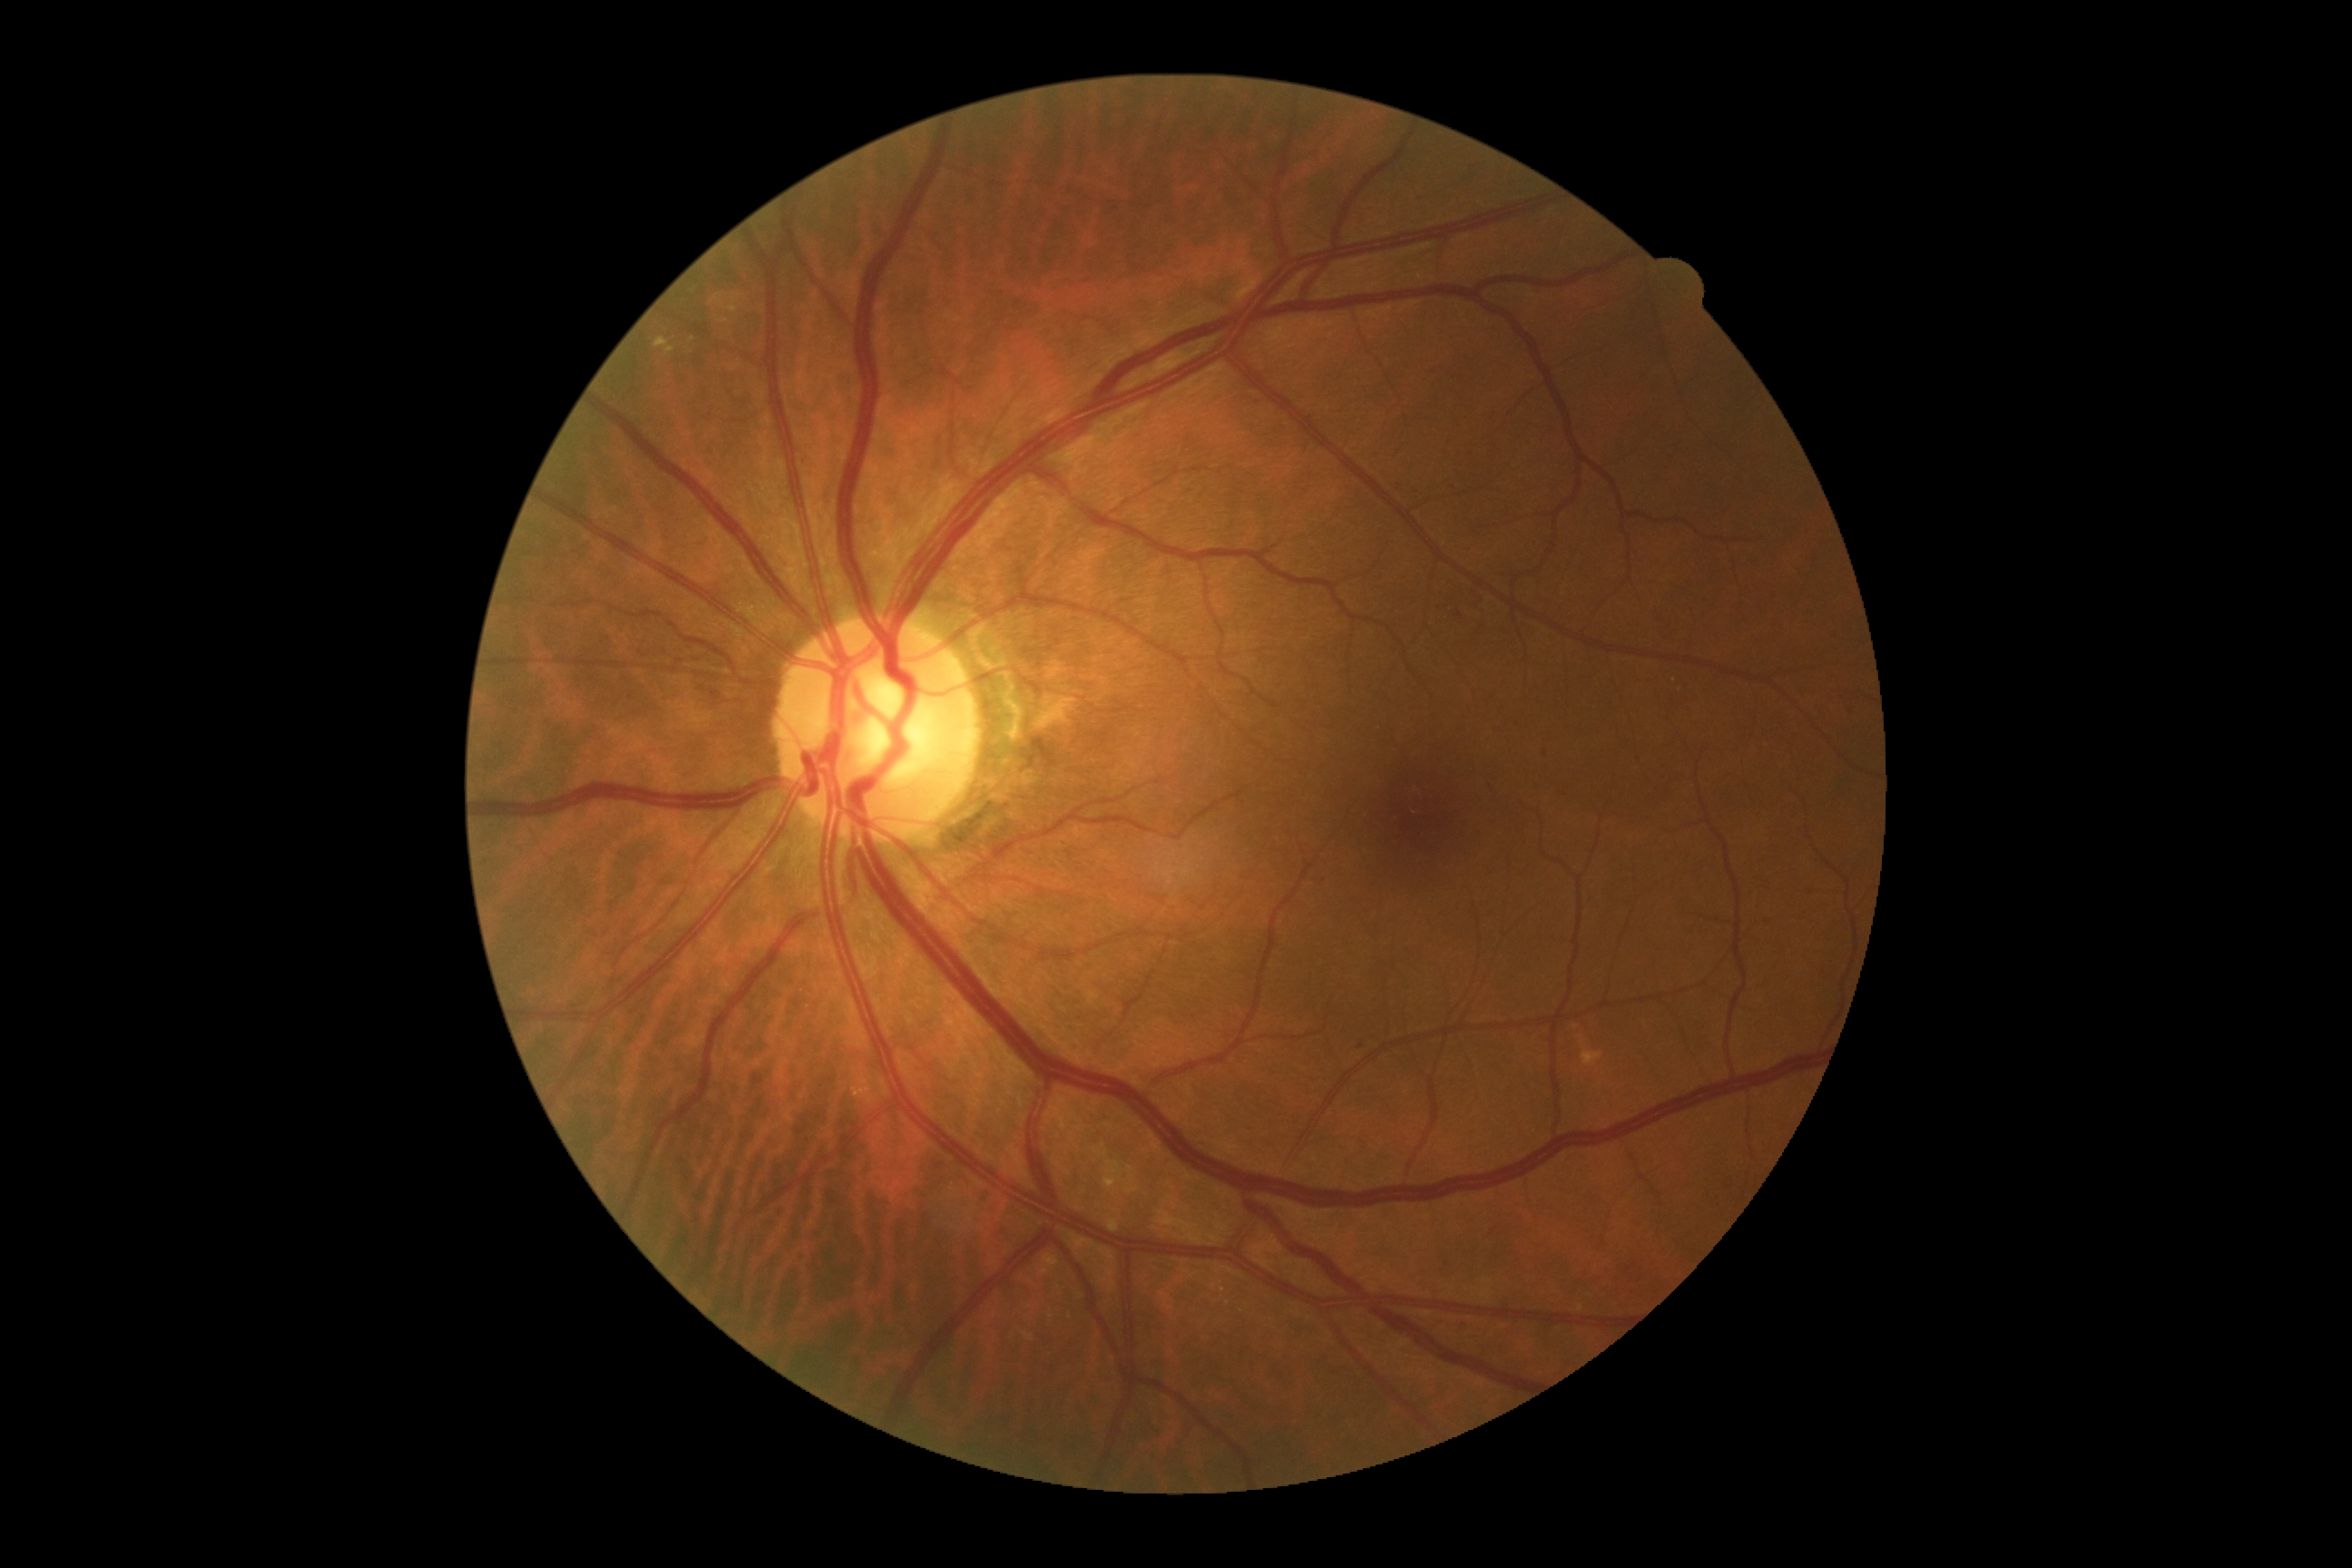
DR class = non-proliferative diabetic retinopathy | retinopathy grade = 2 (moderate NPDR).